NIDEK AFC-230. Modified Davis classification
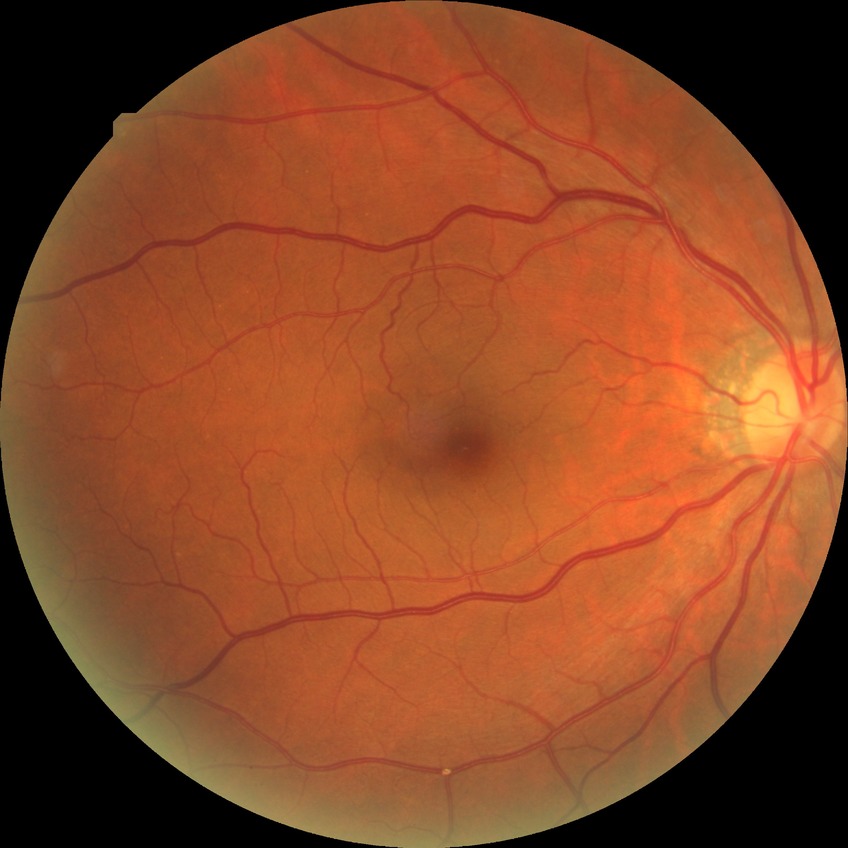

Diabetic retinopathy (DR): NDR (no diabetic retinopathy).